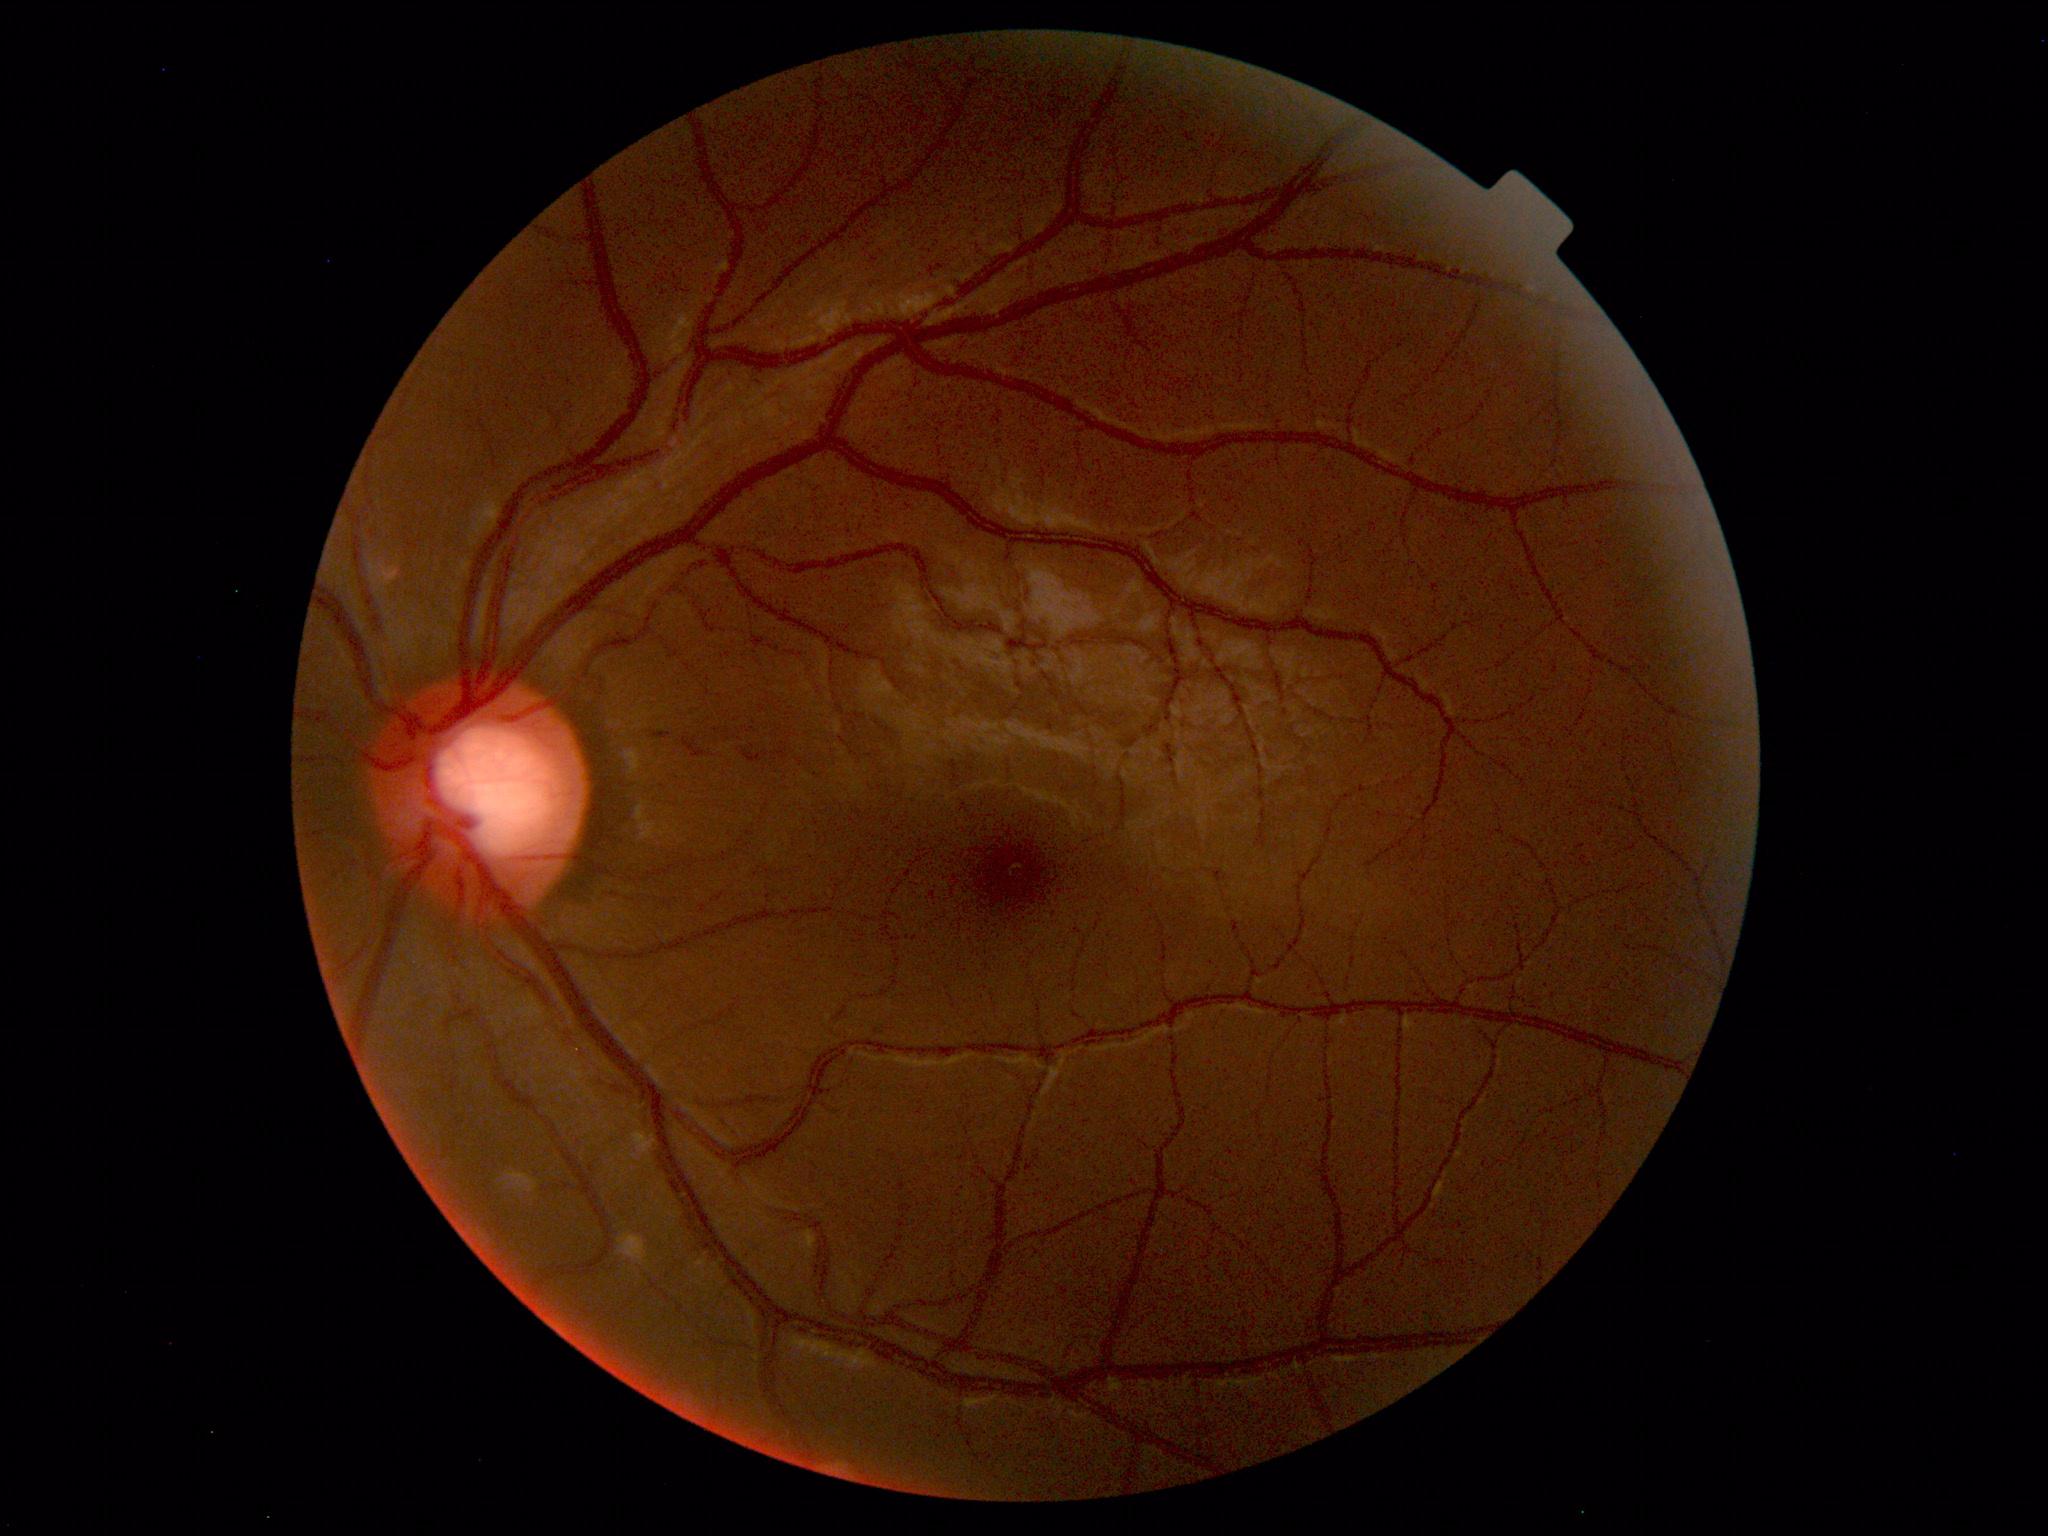
Within normal limits. No abnormalities identified.